Wide-field fundus photograph from neonatal ROP screening
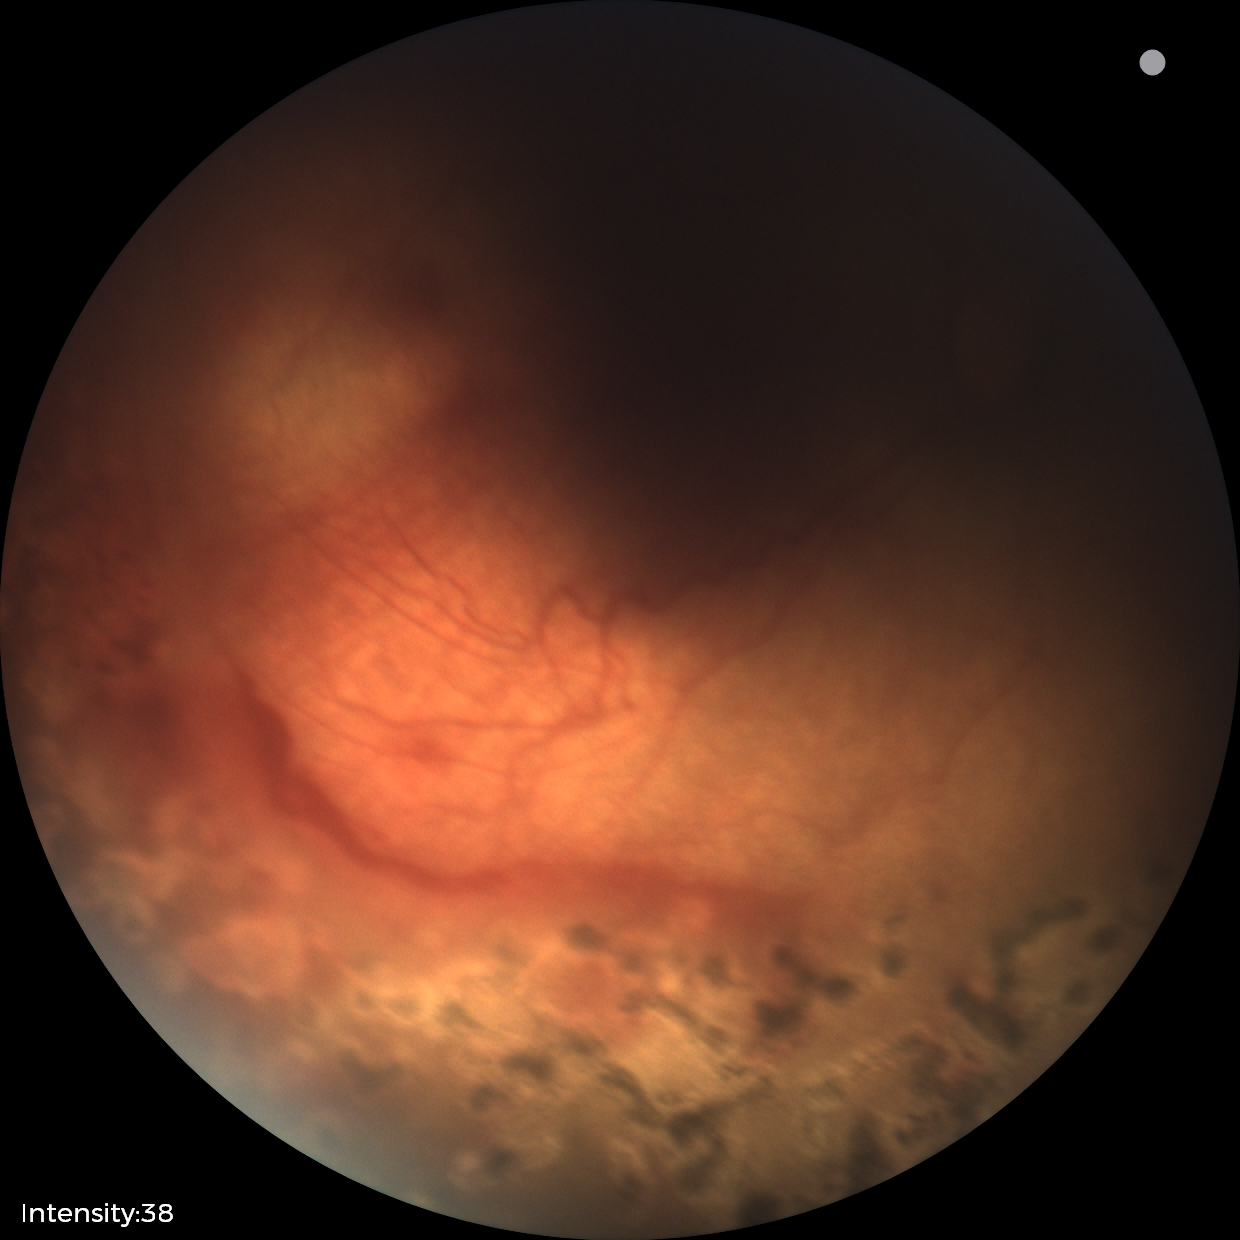
Diagnosis from this screening exam: status post ROP. No plus disease.